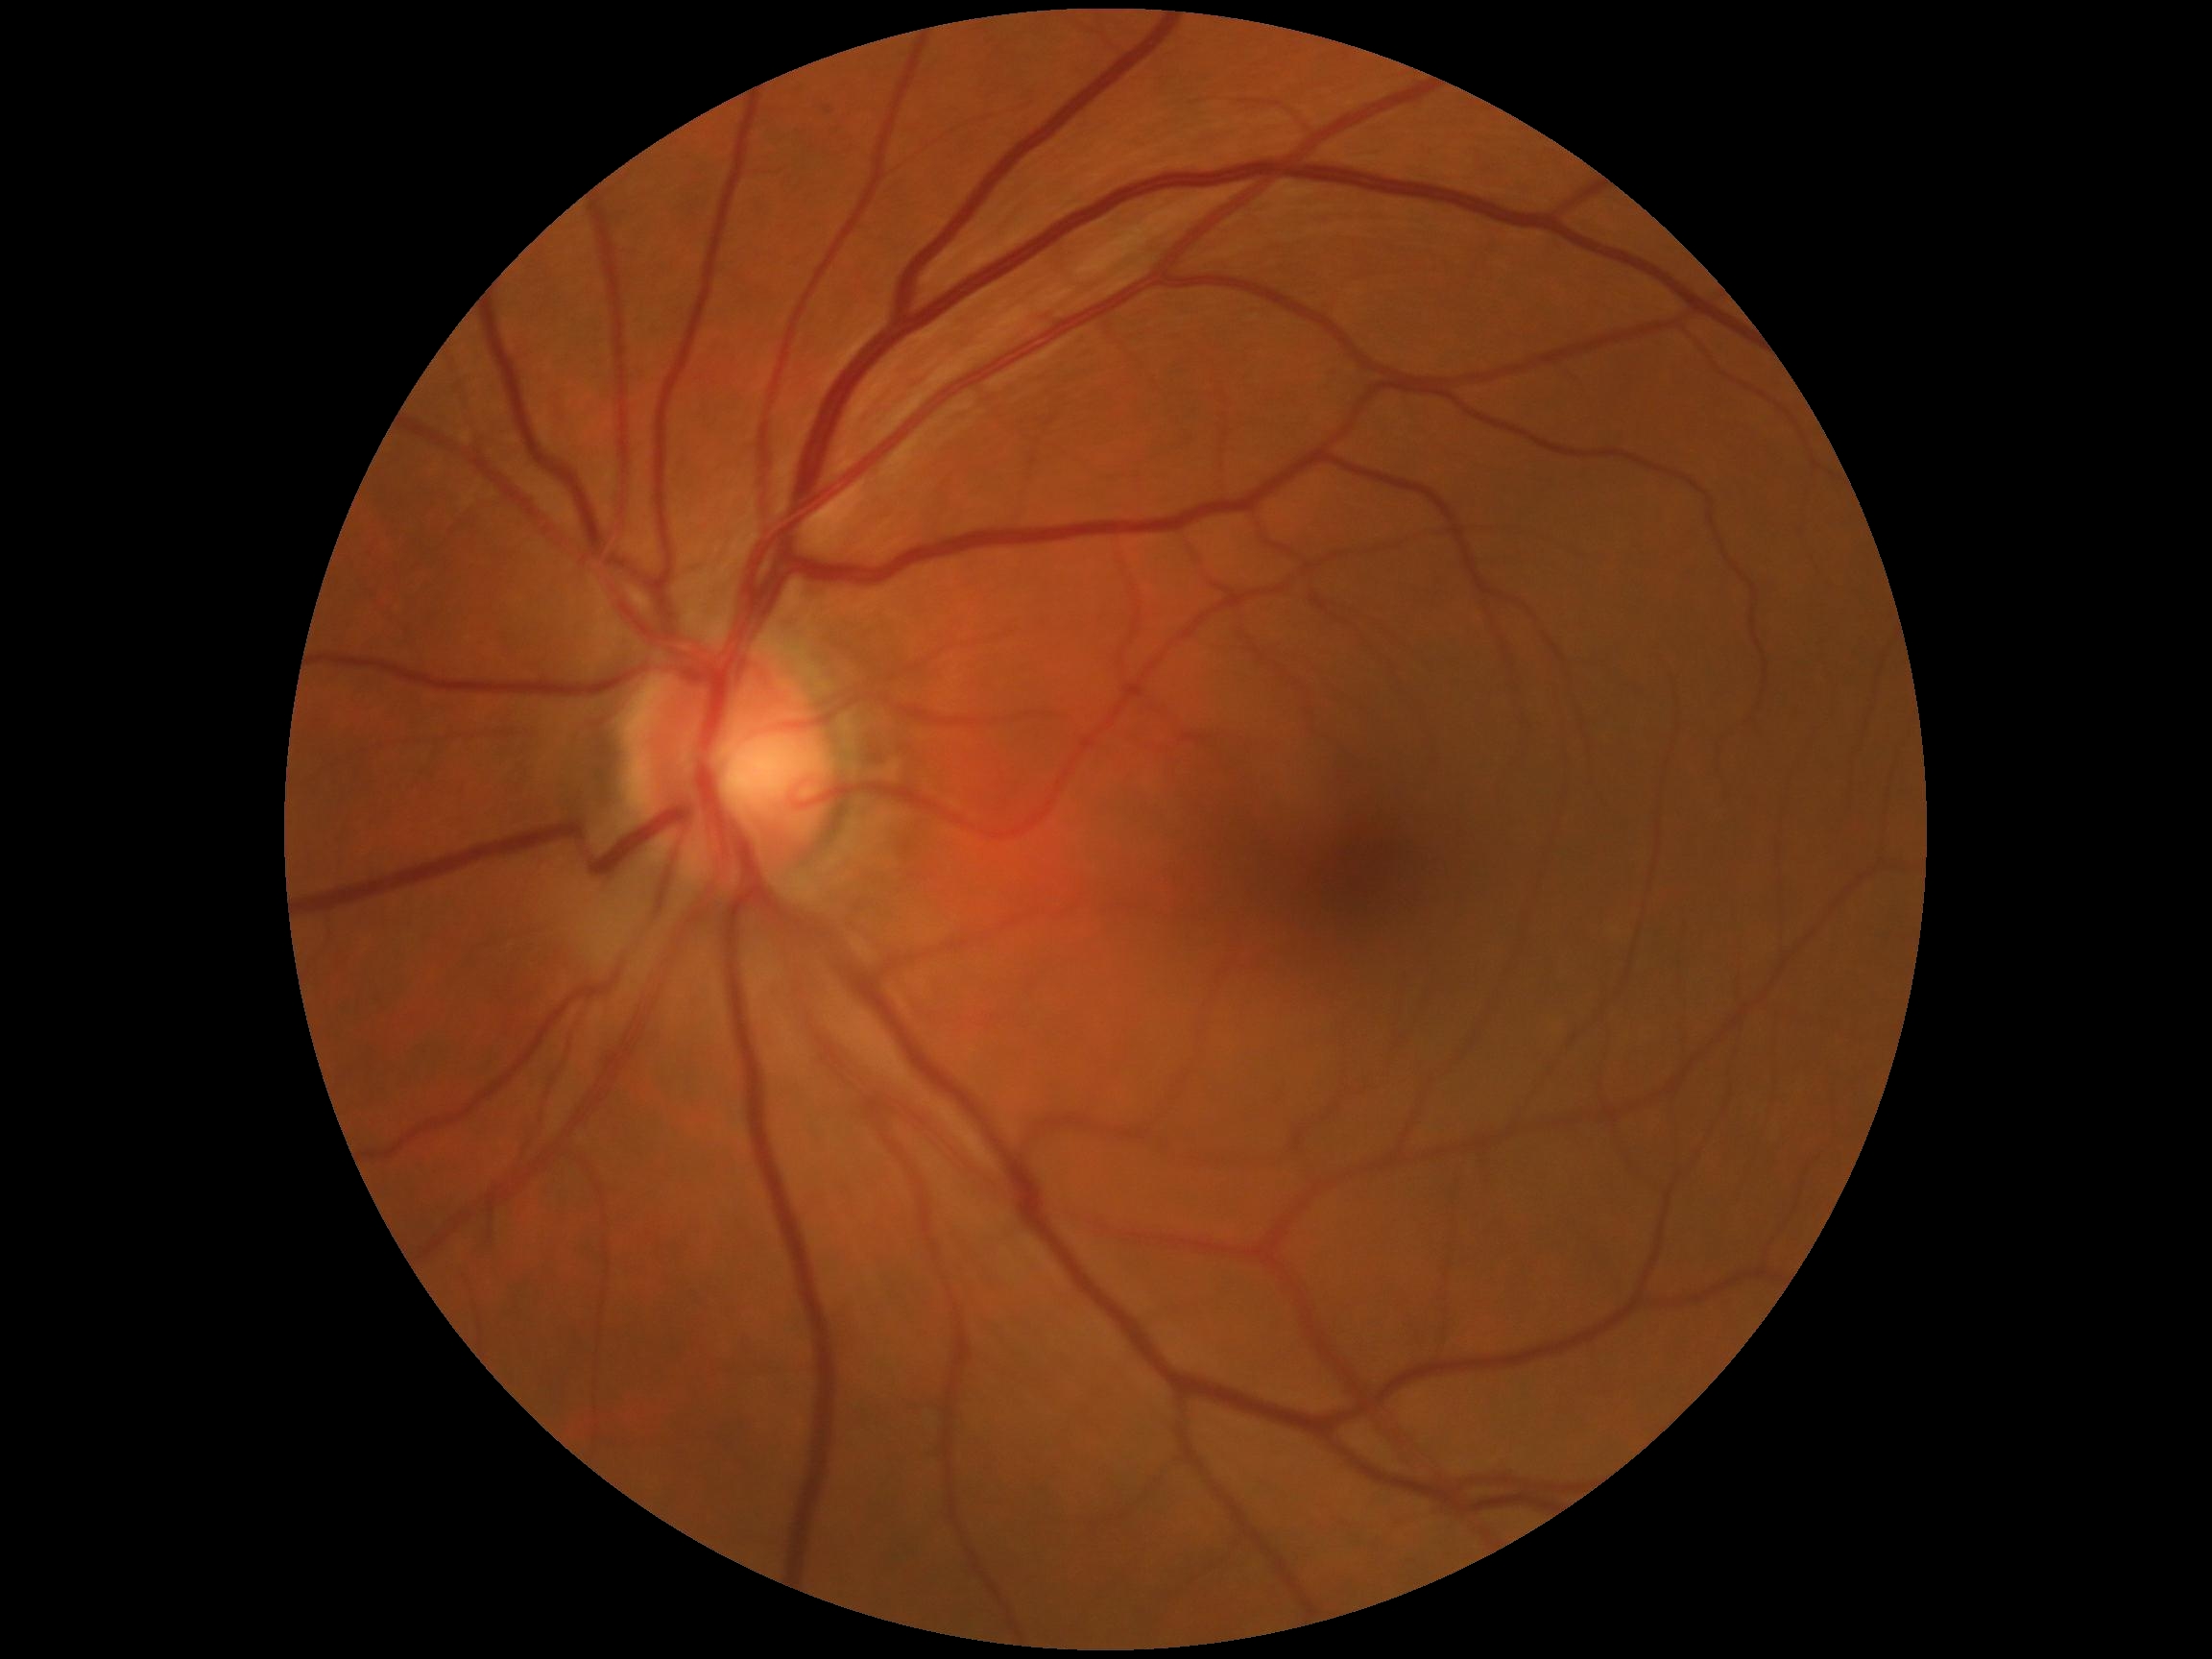

DR is no apparent retinopathy (grade 0).
No signs of diabetic retinopathy.